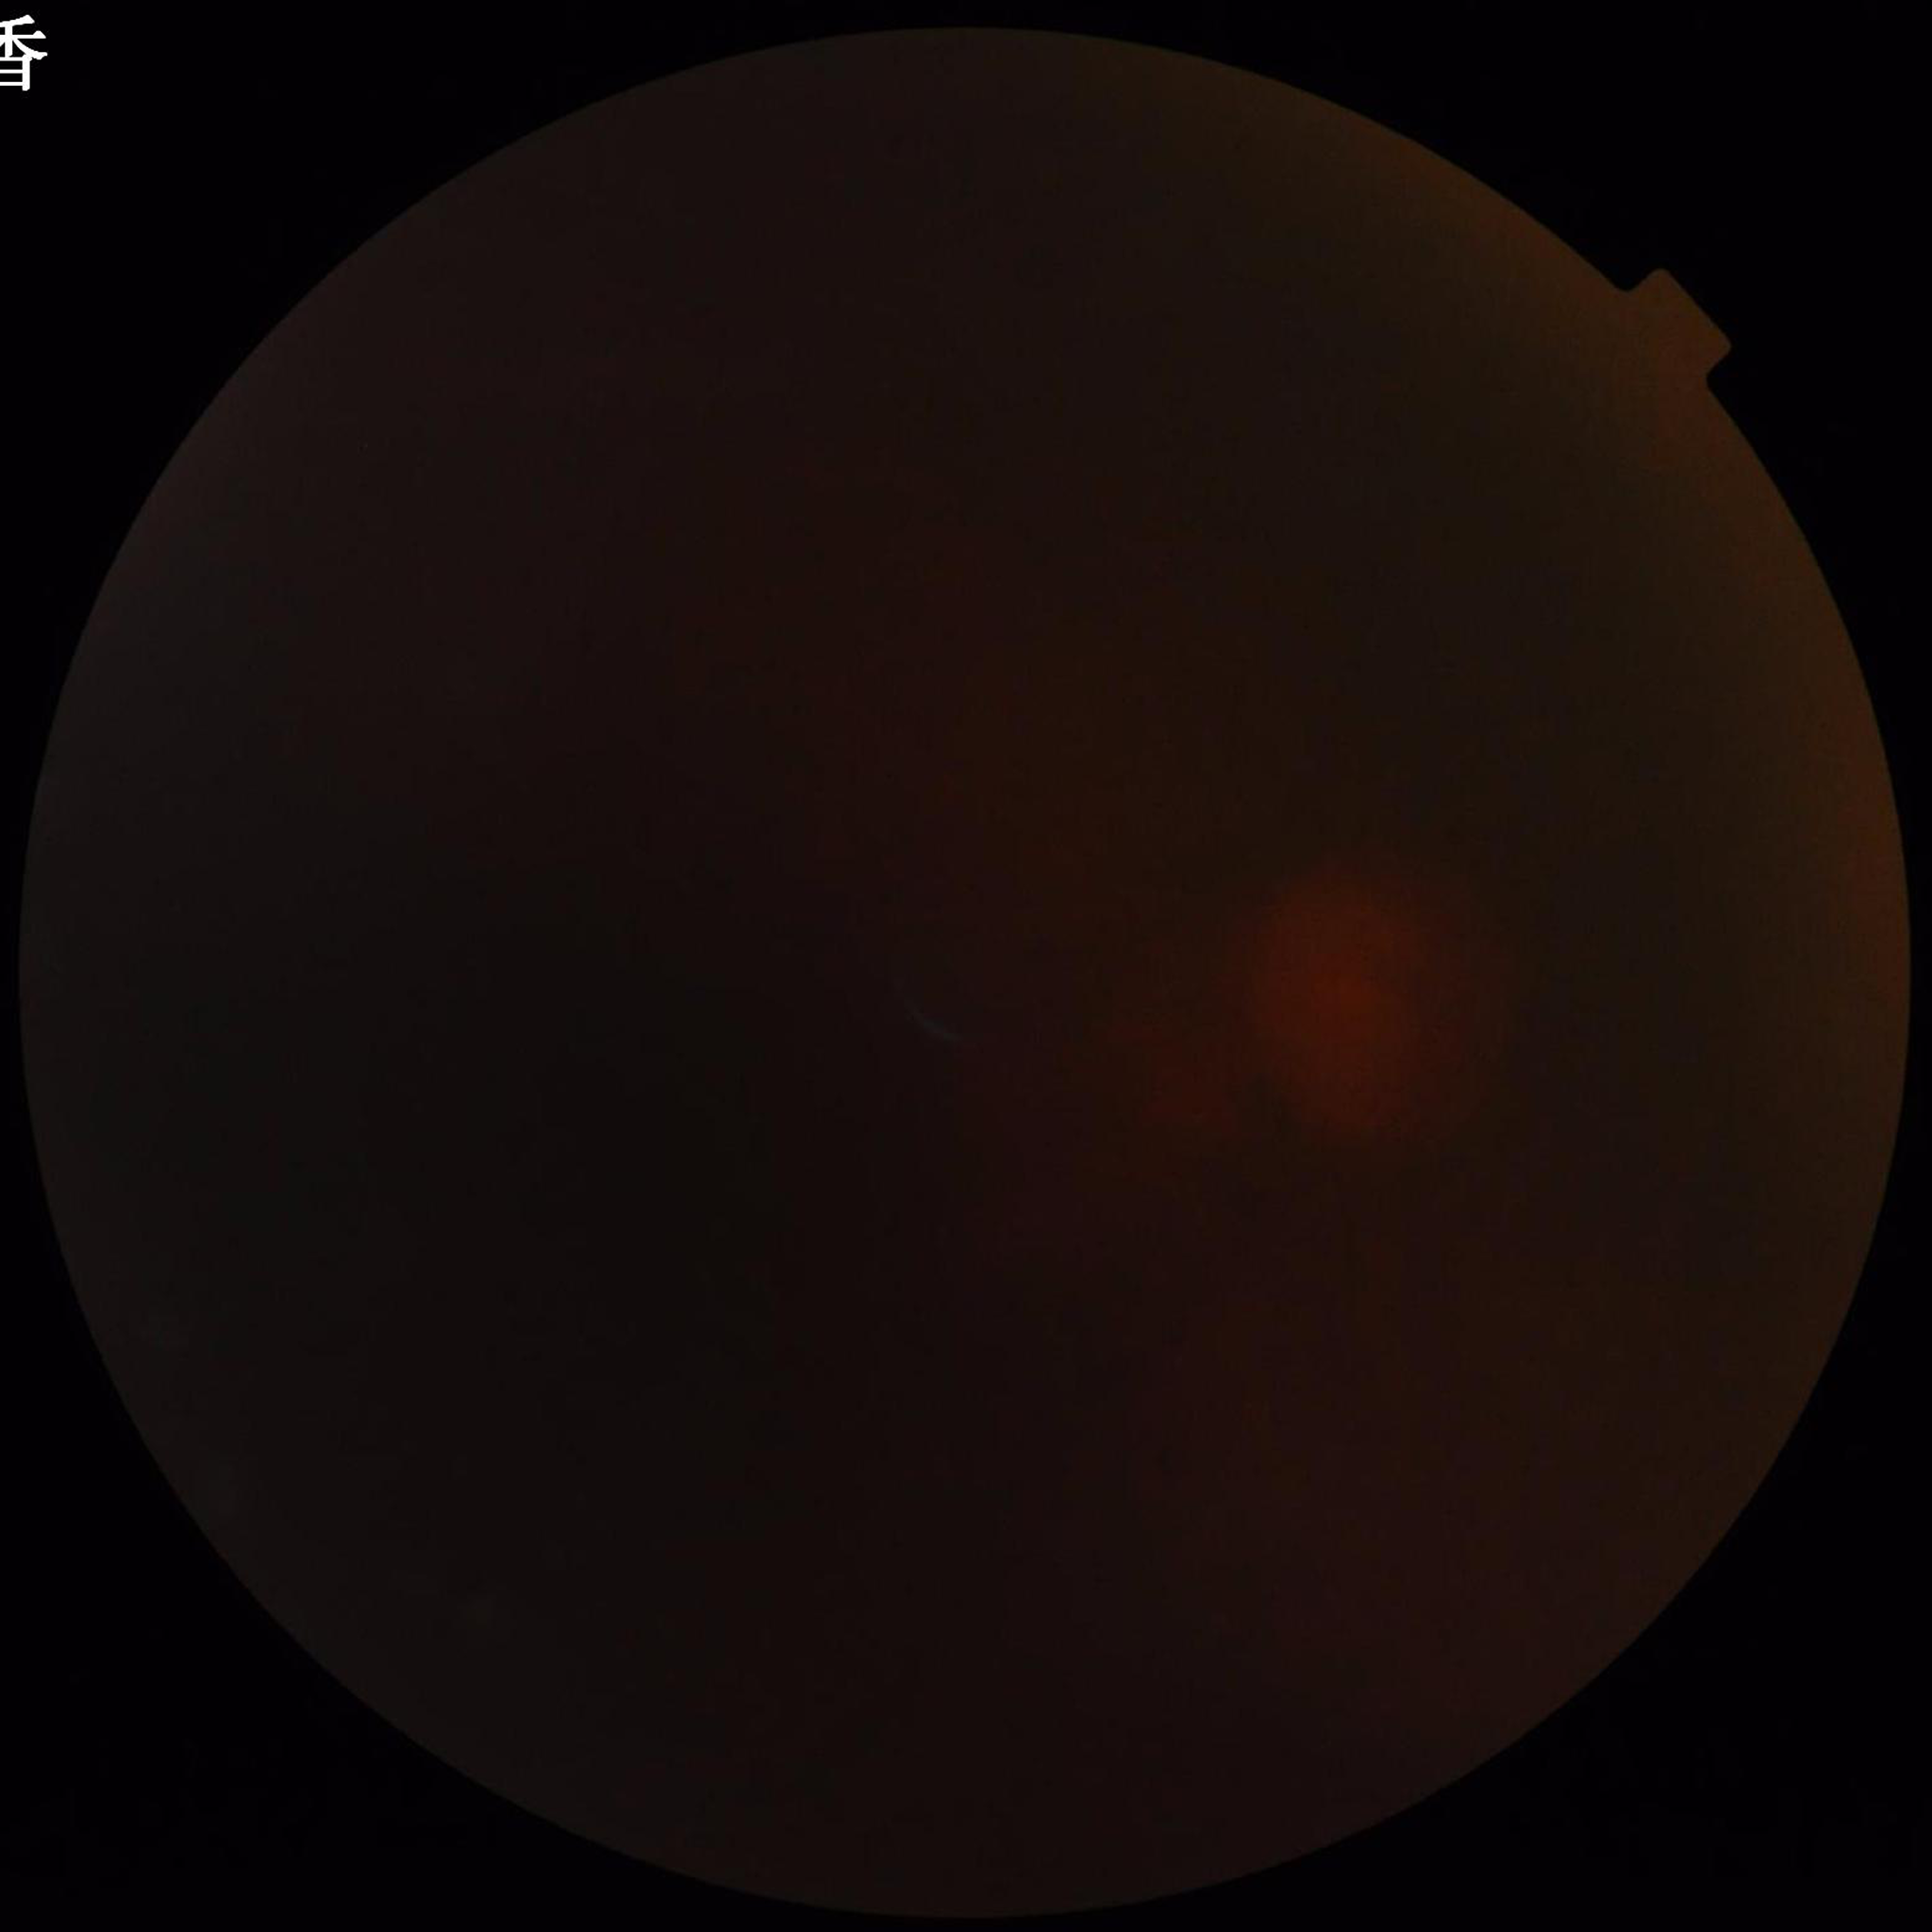 Photo quality: concerns include illumination/color distortion, blur, low contrast; Disease class: glaucoma.